Color fundus photograph: 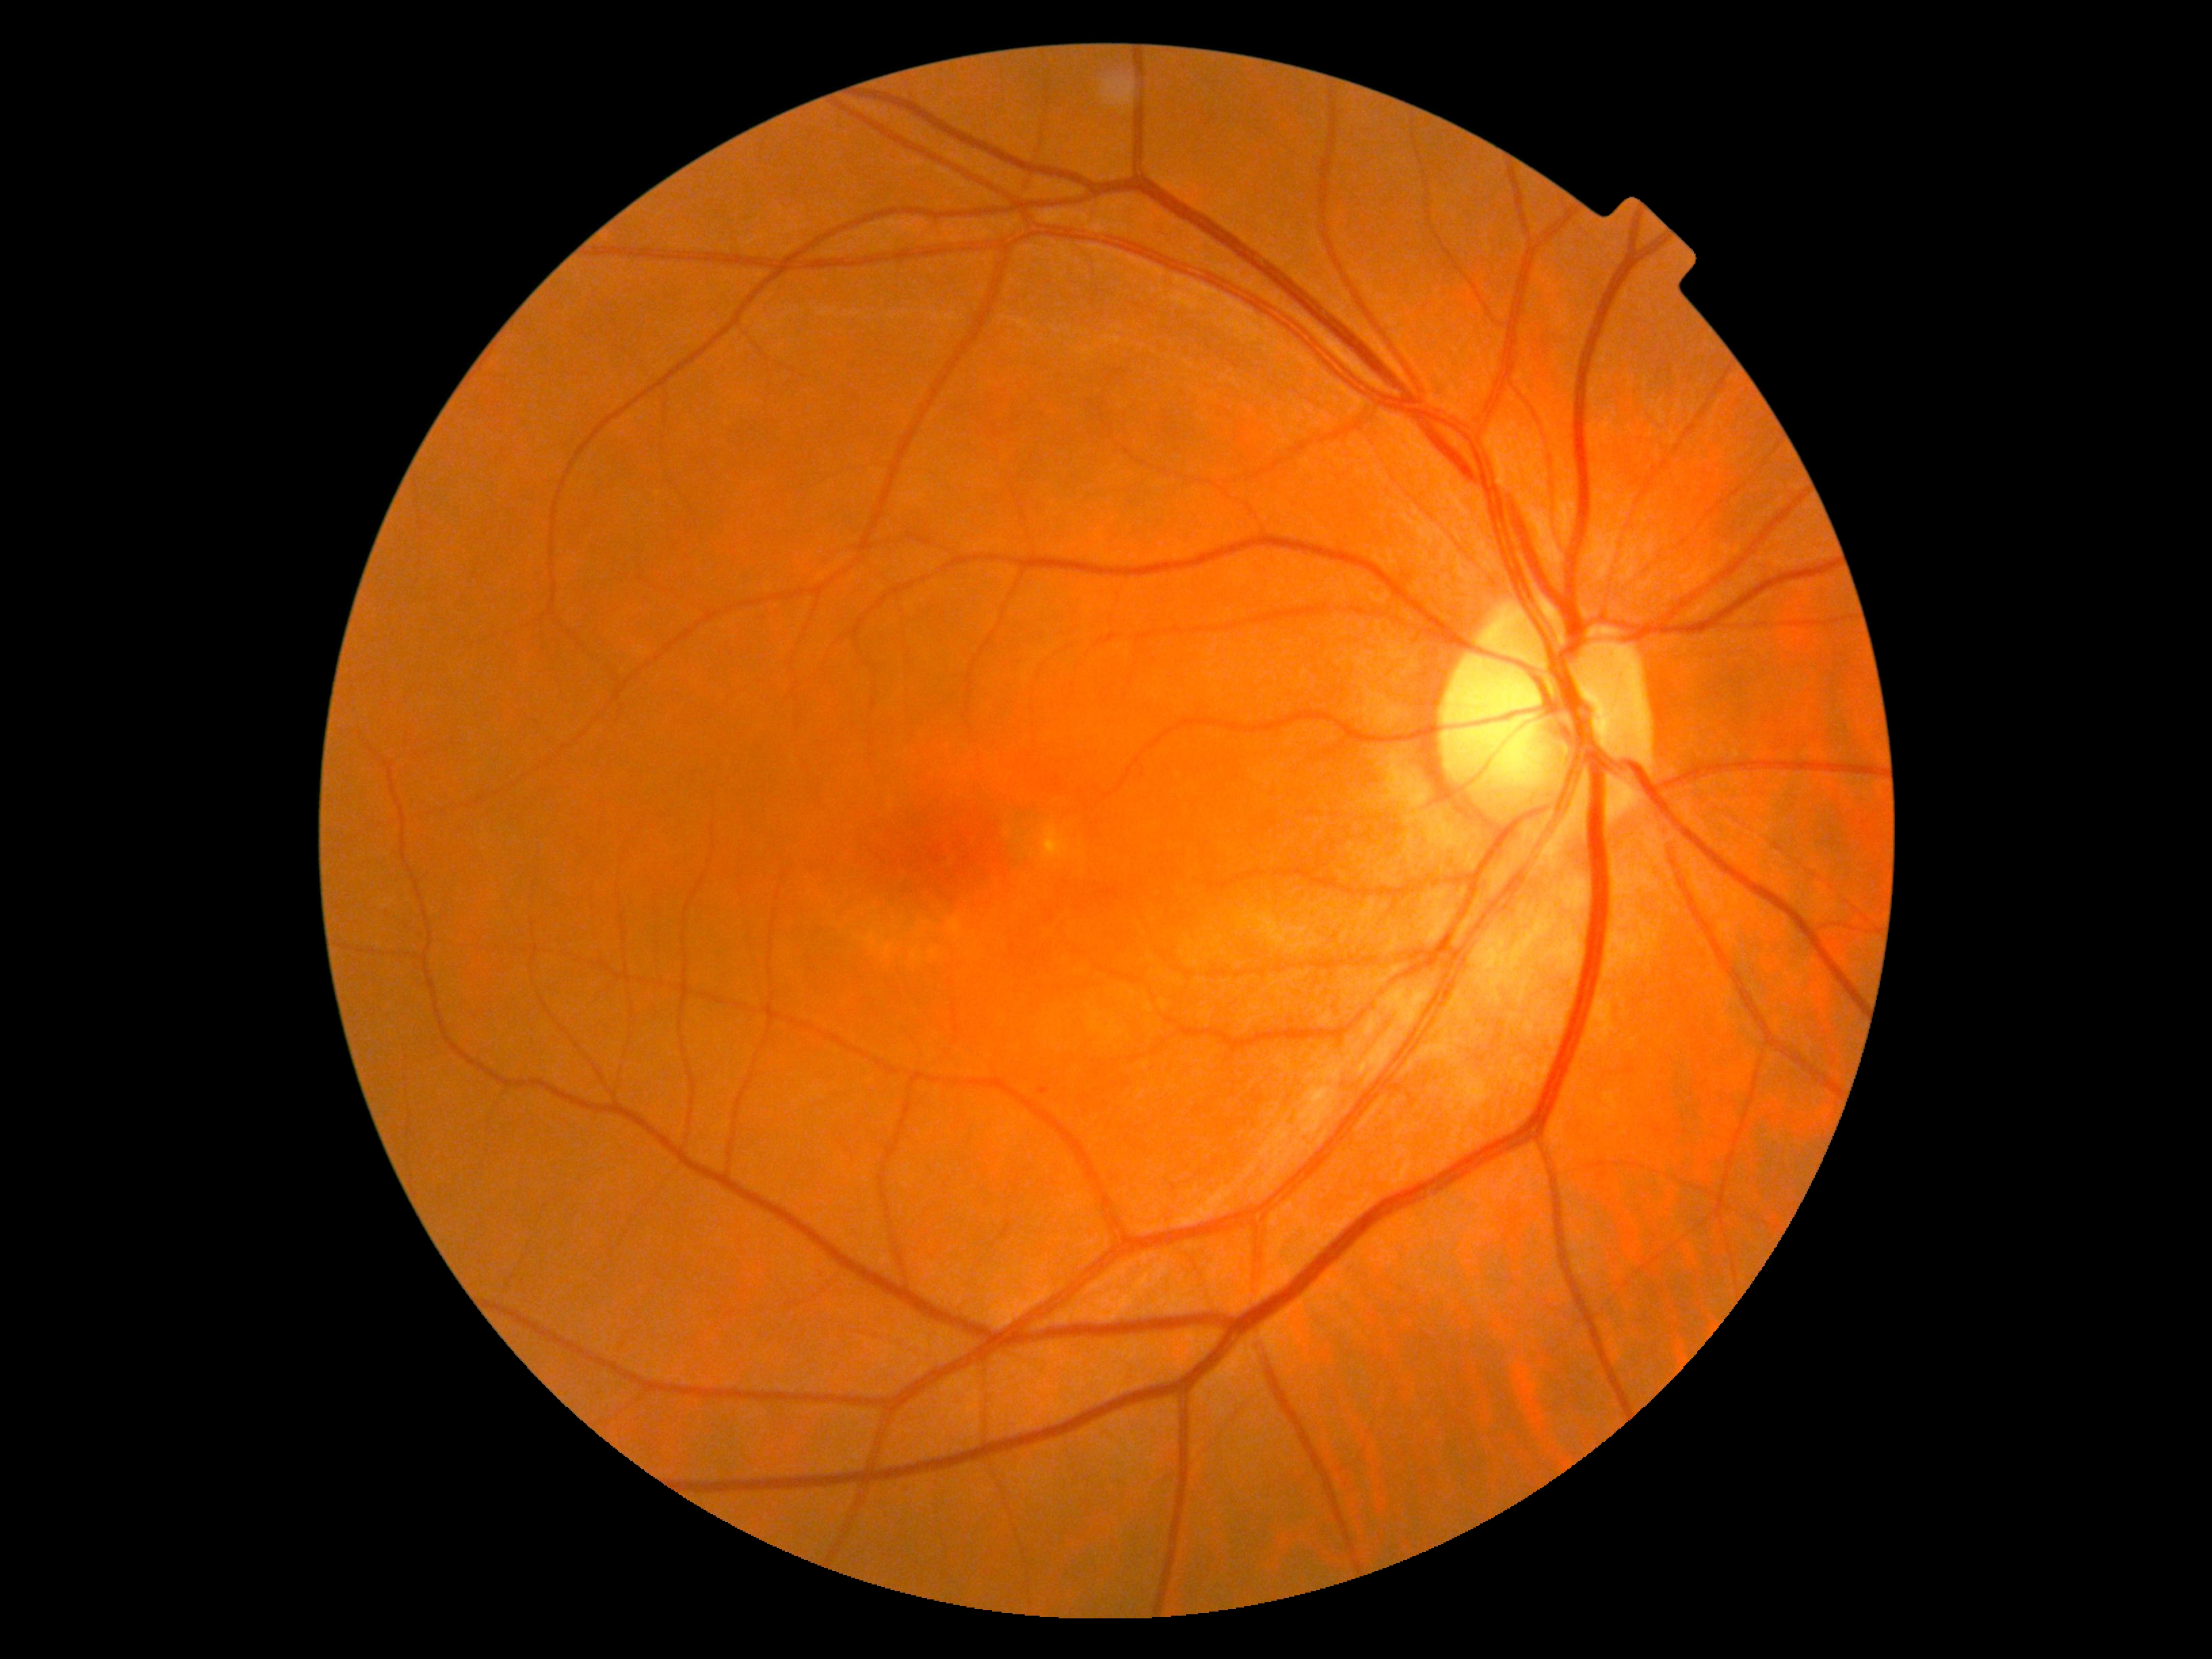
Retinopathy grade: 0.